Refractive error: +5.25 -2 × 100°; IOP (applanation tonometry): 17 mmHg; axial length 21.81 mm; 2212x1661px; age 53: 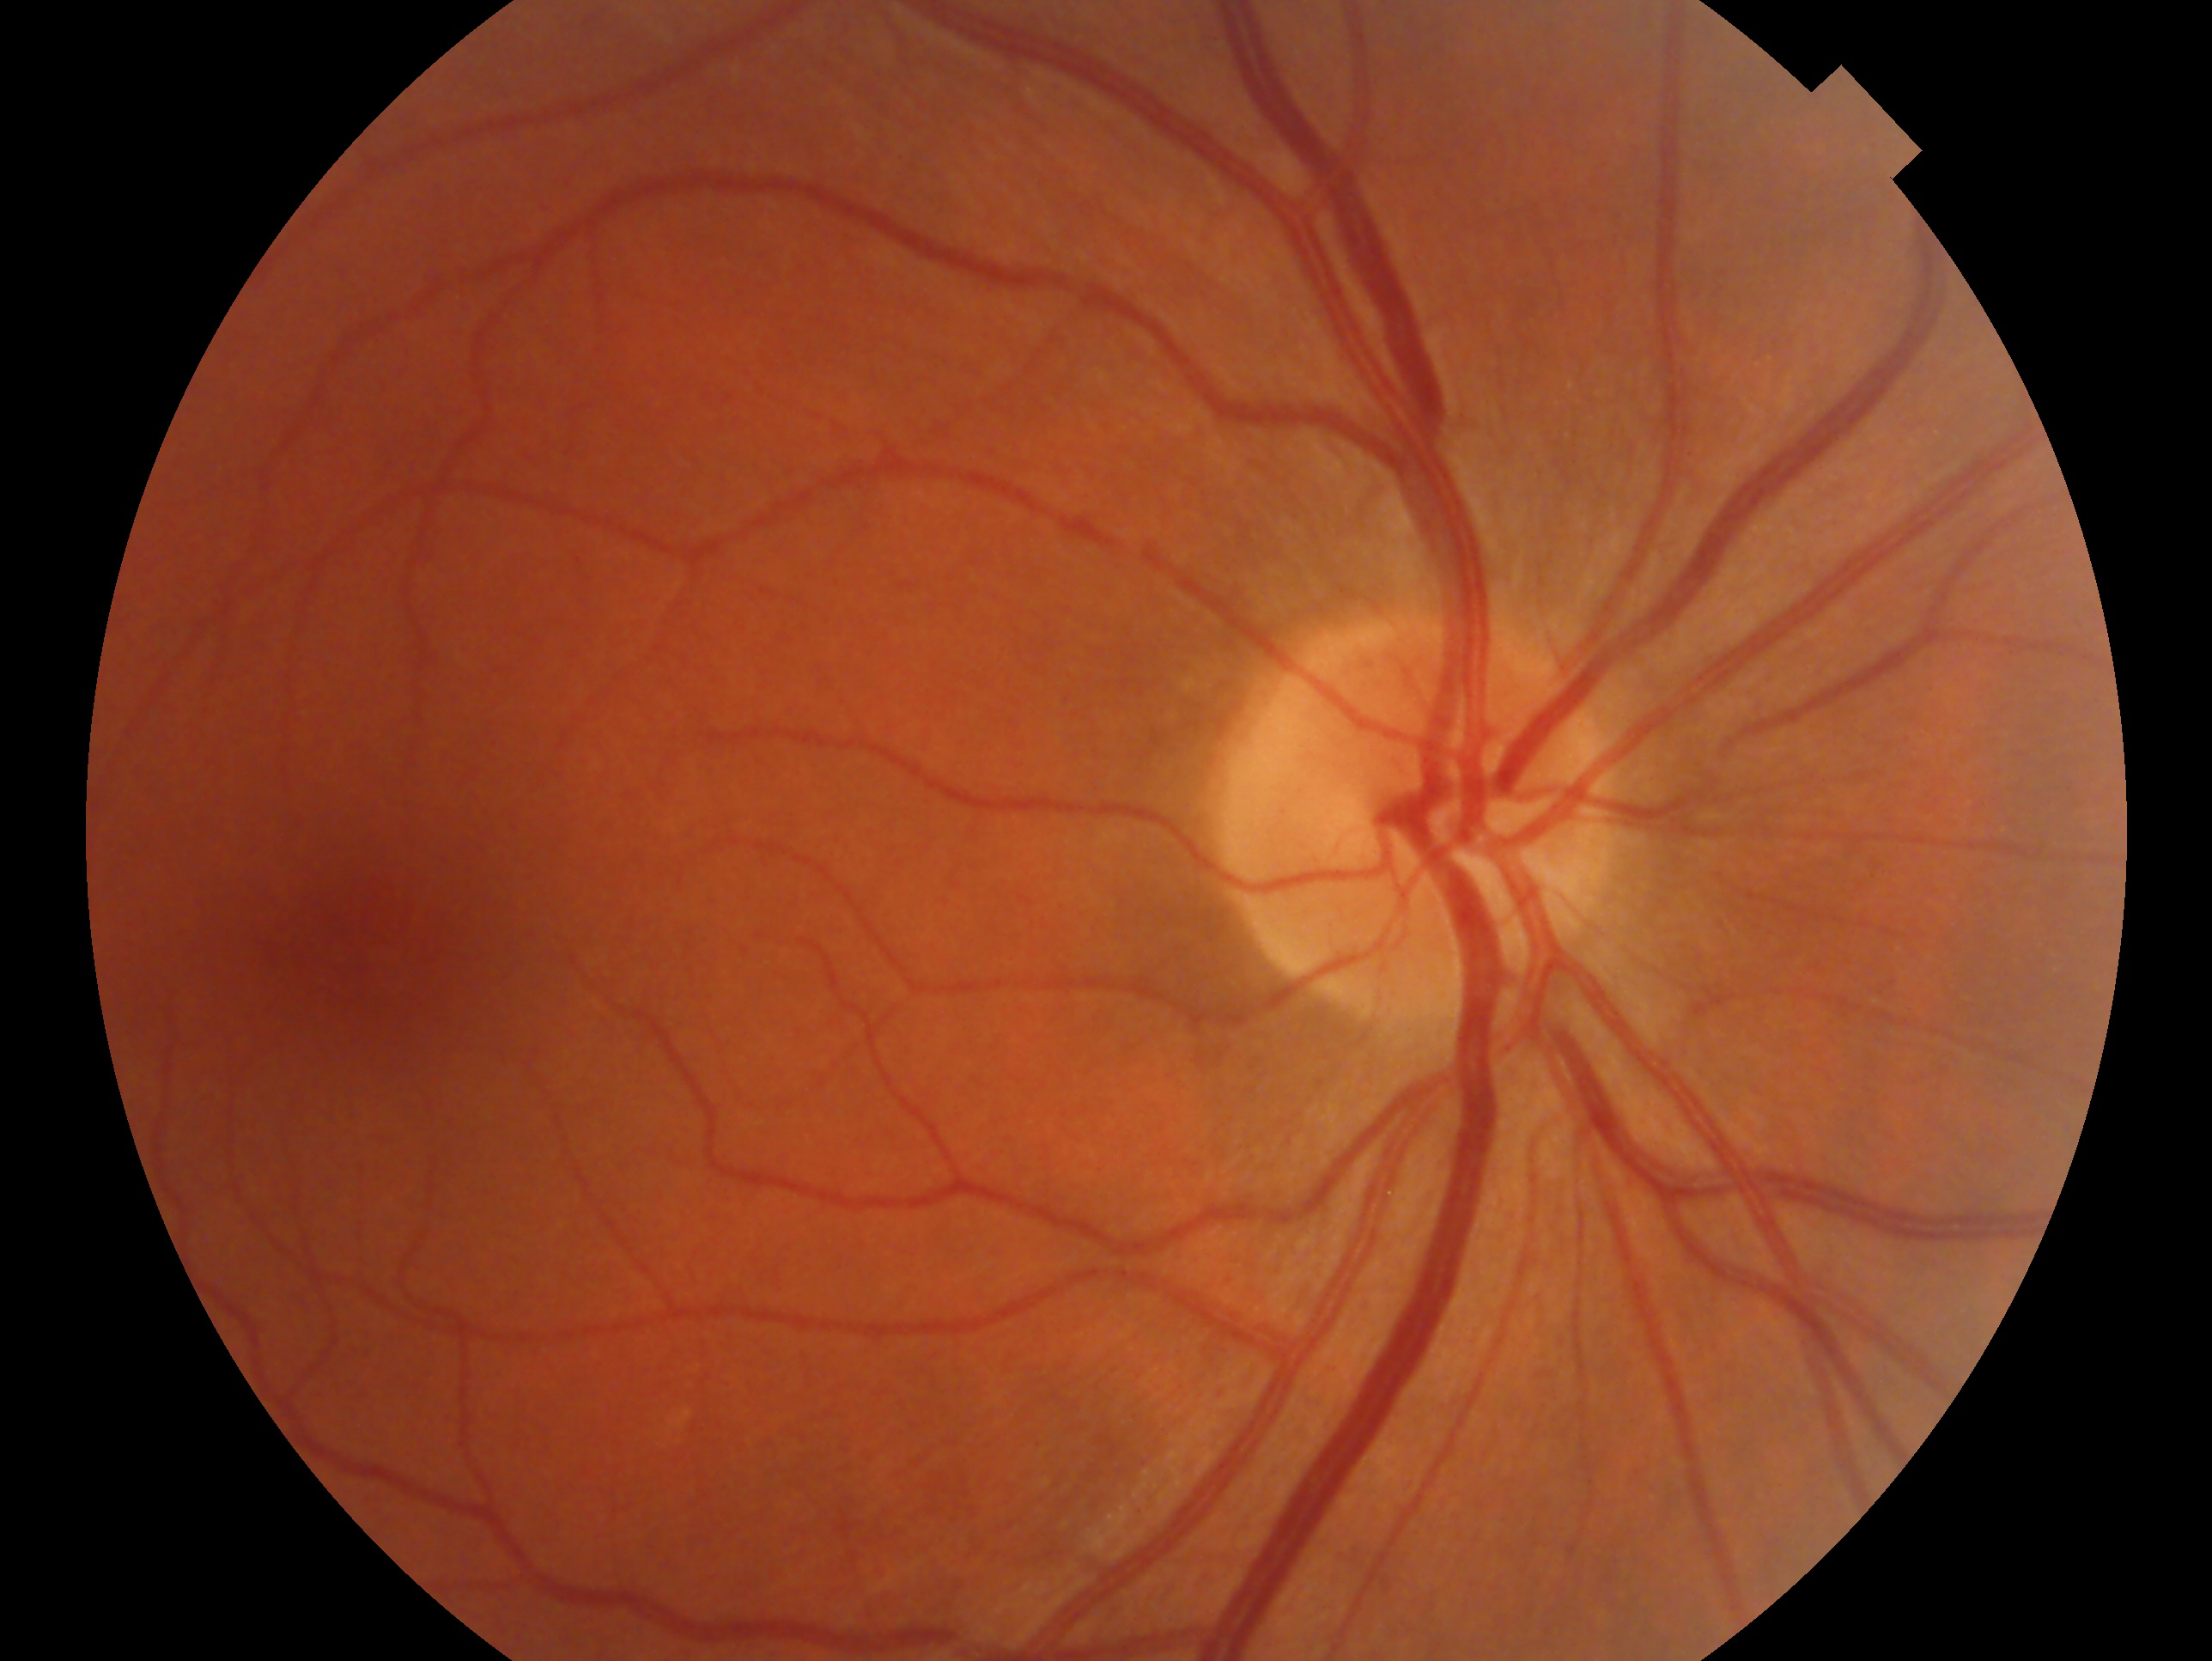 Clinical classification: suspected glaucoma — risk factors or equivocal findings for glaucoma without a confirmed diagnosis.
Imaged eye: right eye.